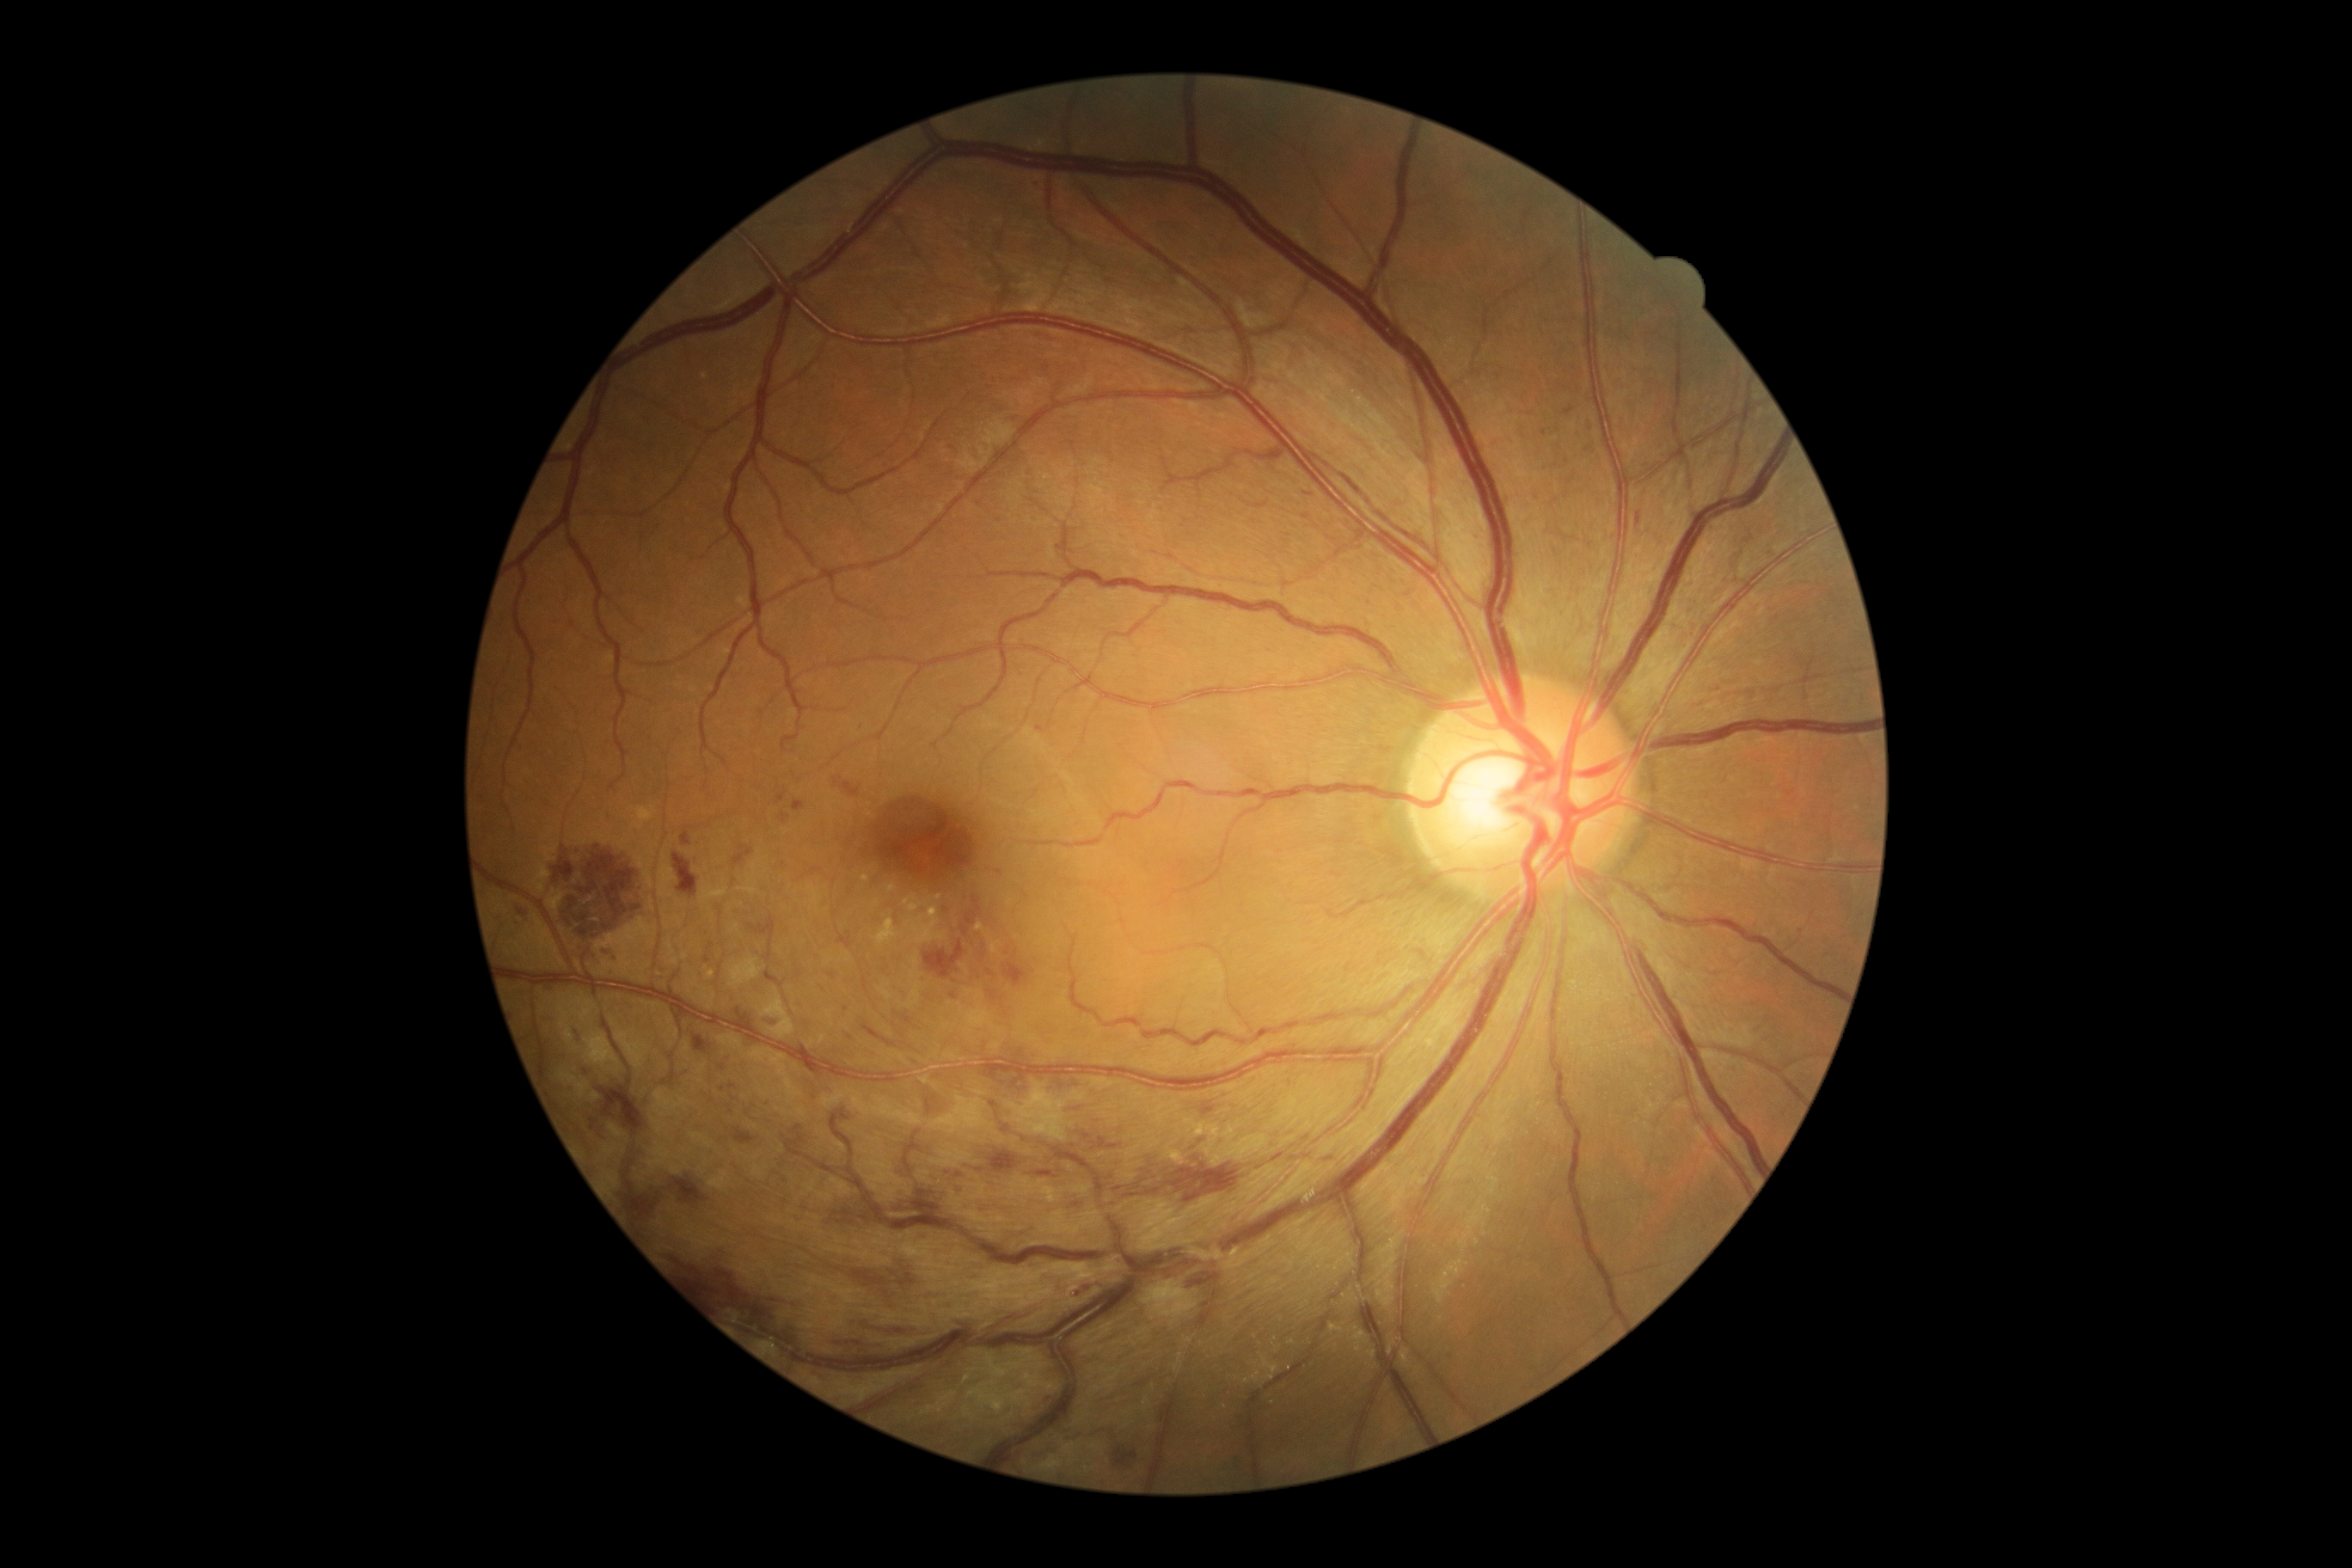 DR class: non-proliferative diabetic retinopathy.
Retinopathy grade: moderate NPDR (2) — more than just microaneurysms but less than severe NPDR.